Image size 2184x1690; 45° FOV; retinal fundus photograph:
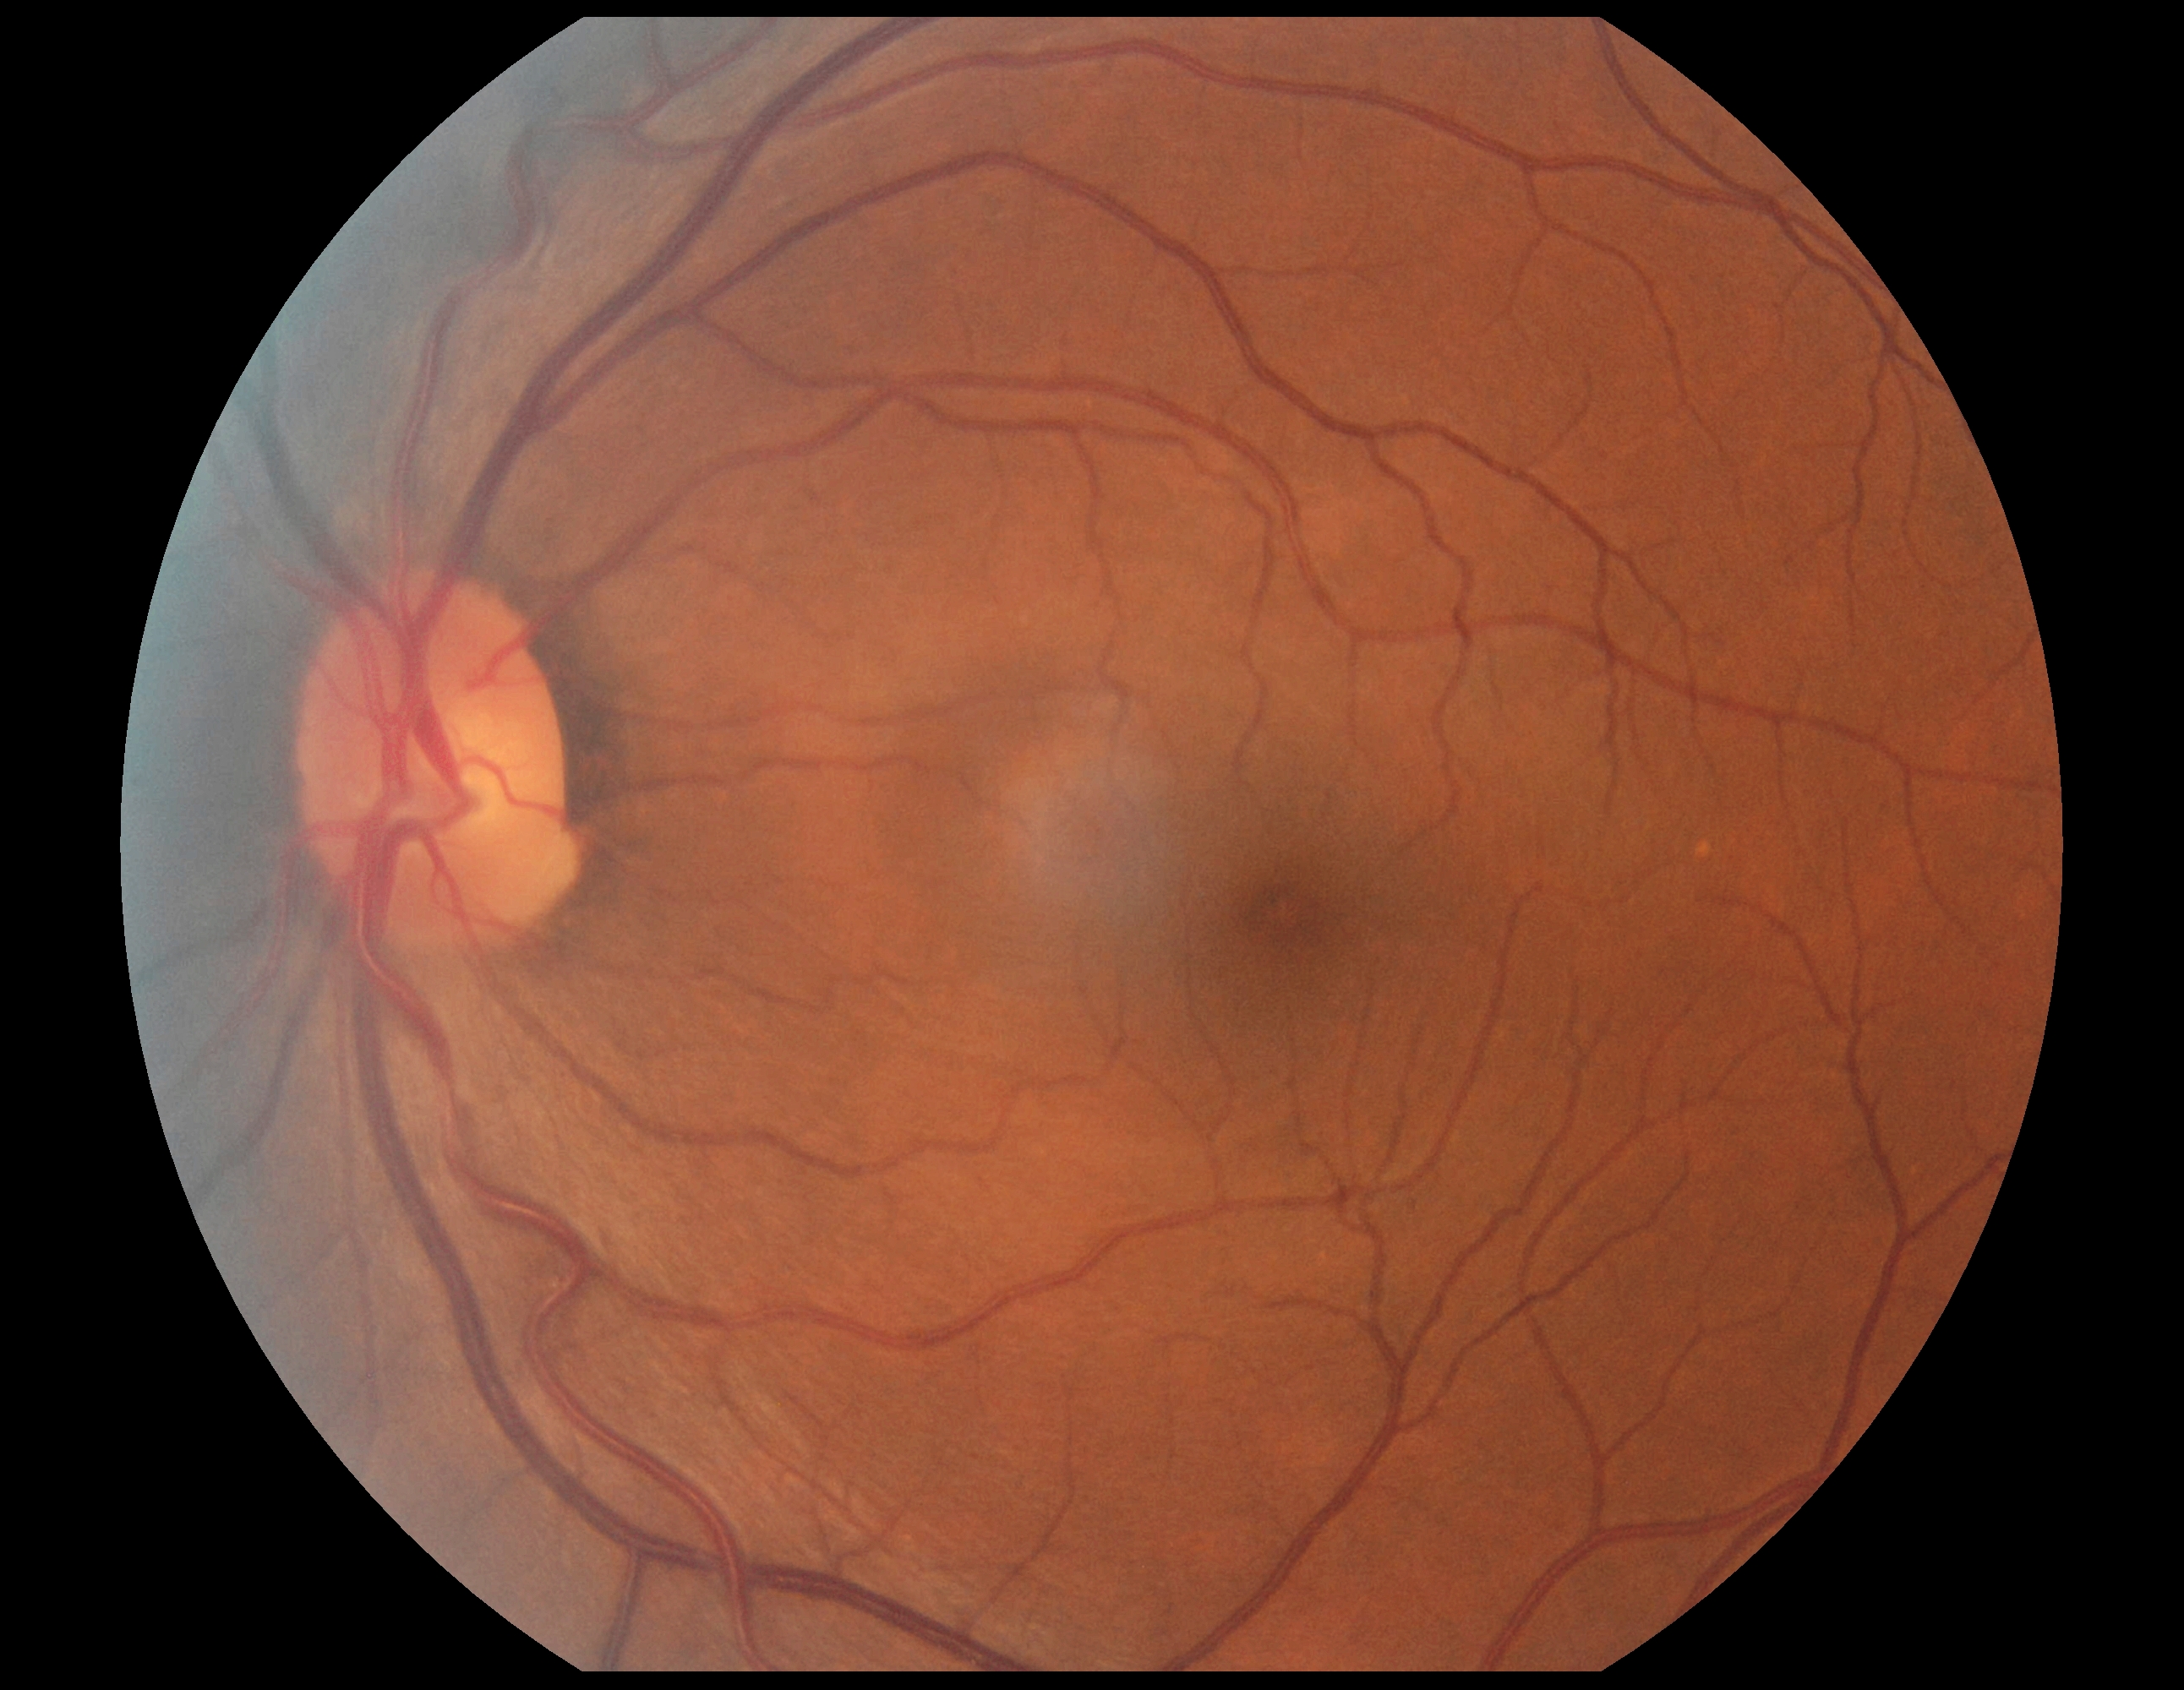 DR severity: 0/4 — no visible signs of diabetic retinopathy.